Retinal fundus photograph; non-mydriatic — 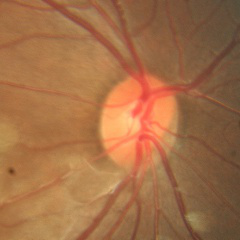
No glaucomatous findings.